Nidek AFC-330, disc-centered field.
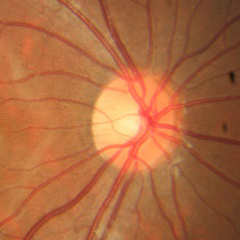

Optic nerve head appearance consistent with no signs of glaucoma.